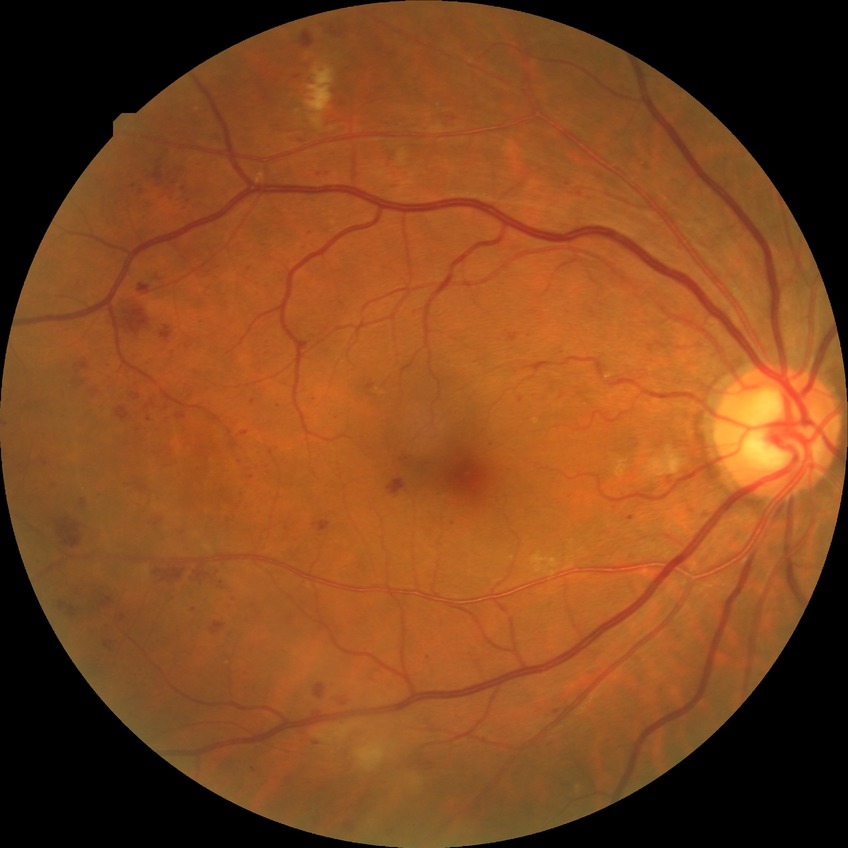 Davis grading: pre-proliferative diabetic retinopathy.